Fundus photo.
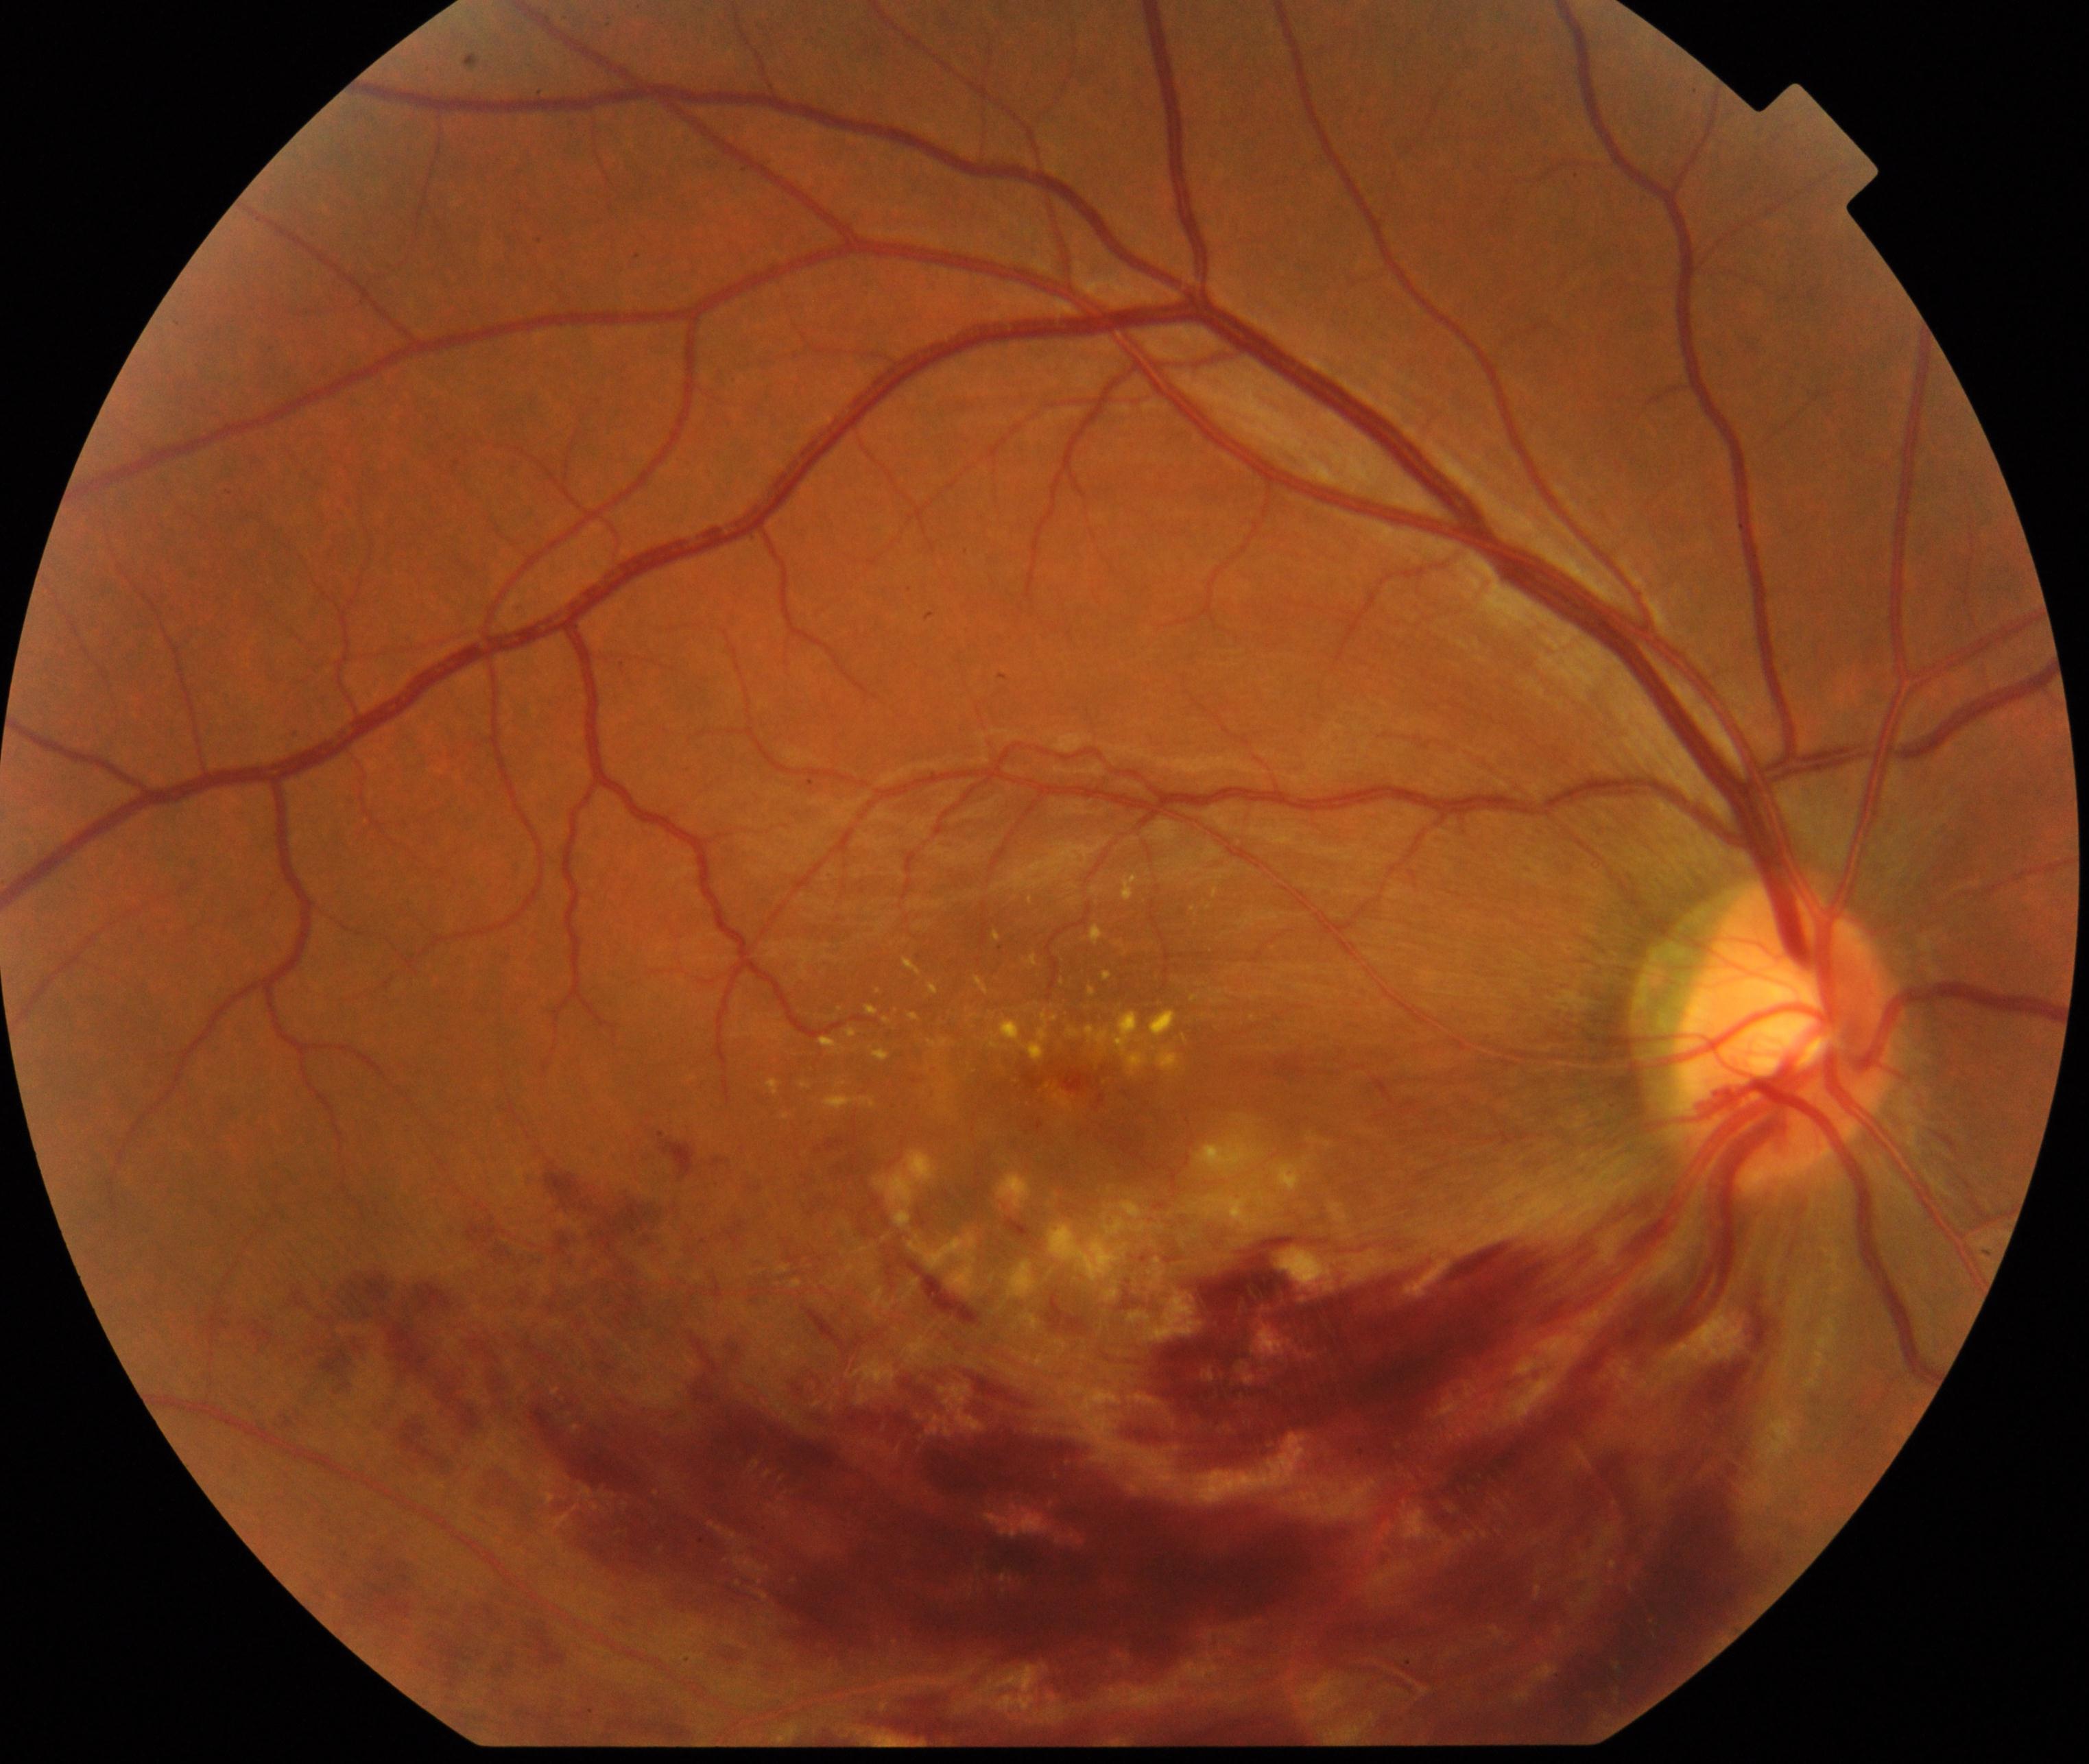 The image shows branch retinal vein occlusion.